Without pupil dilation · Davis DR grading: 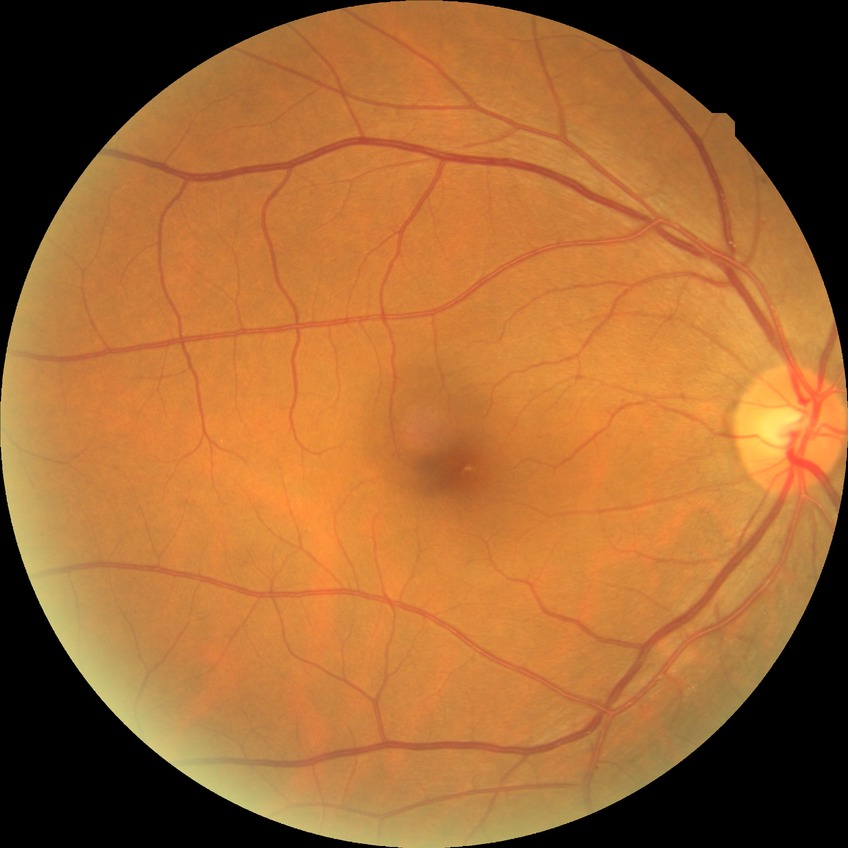 DR stage=SDR.